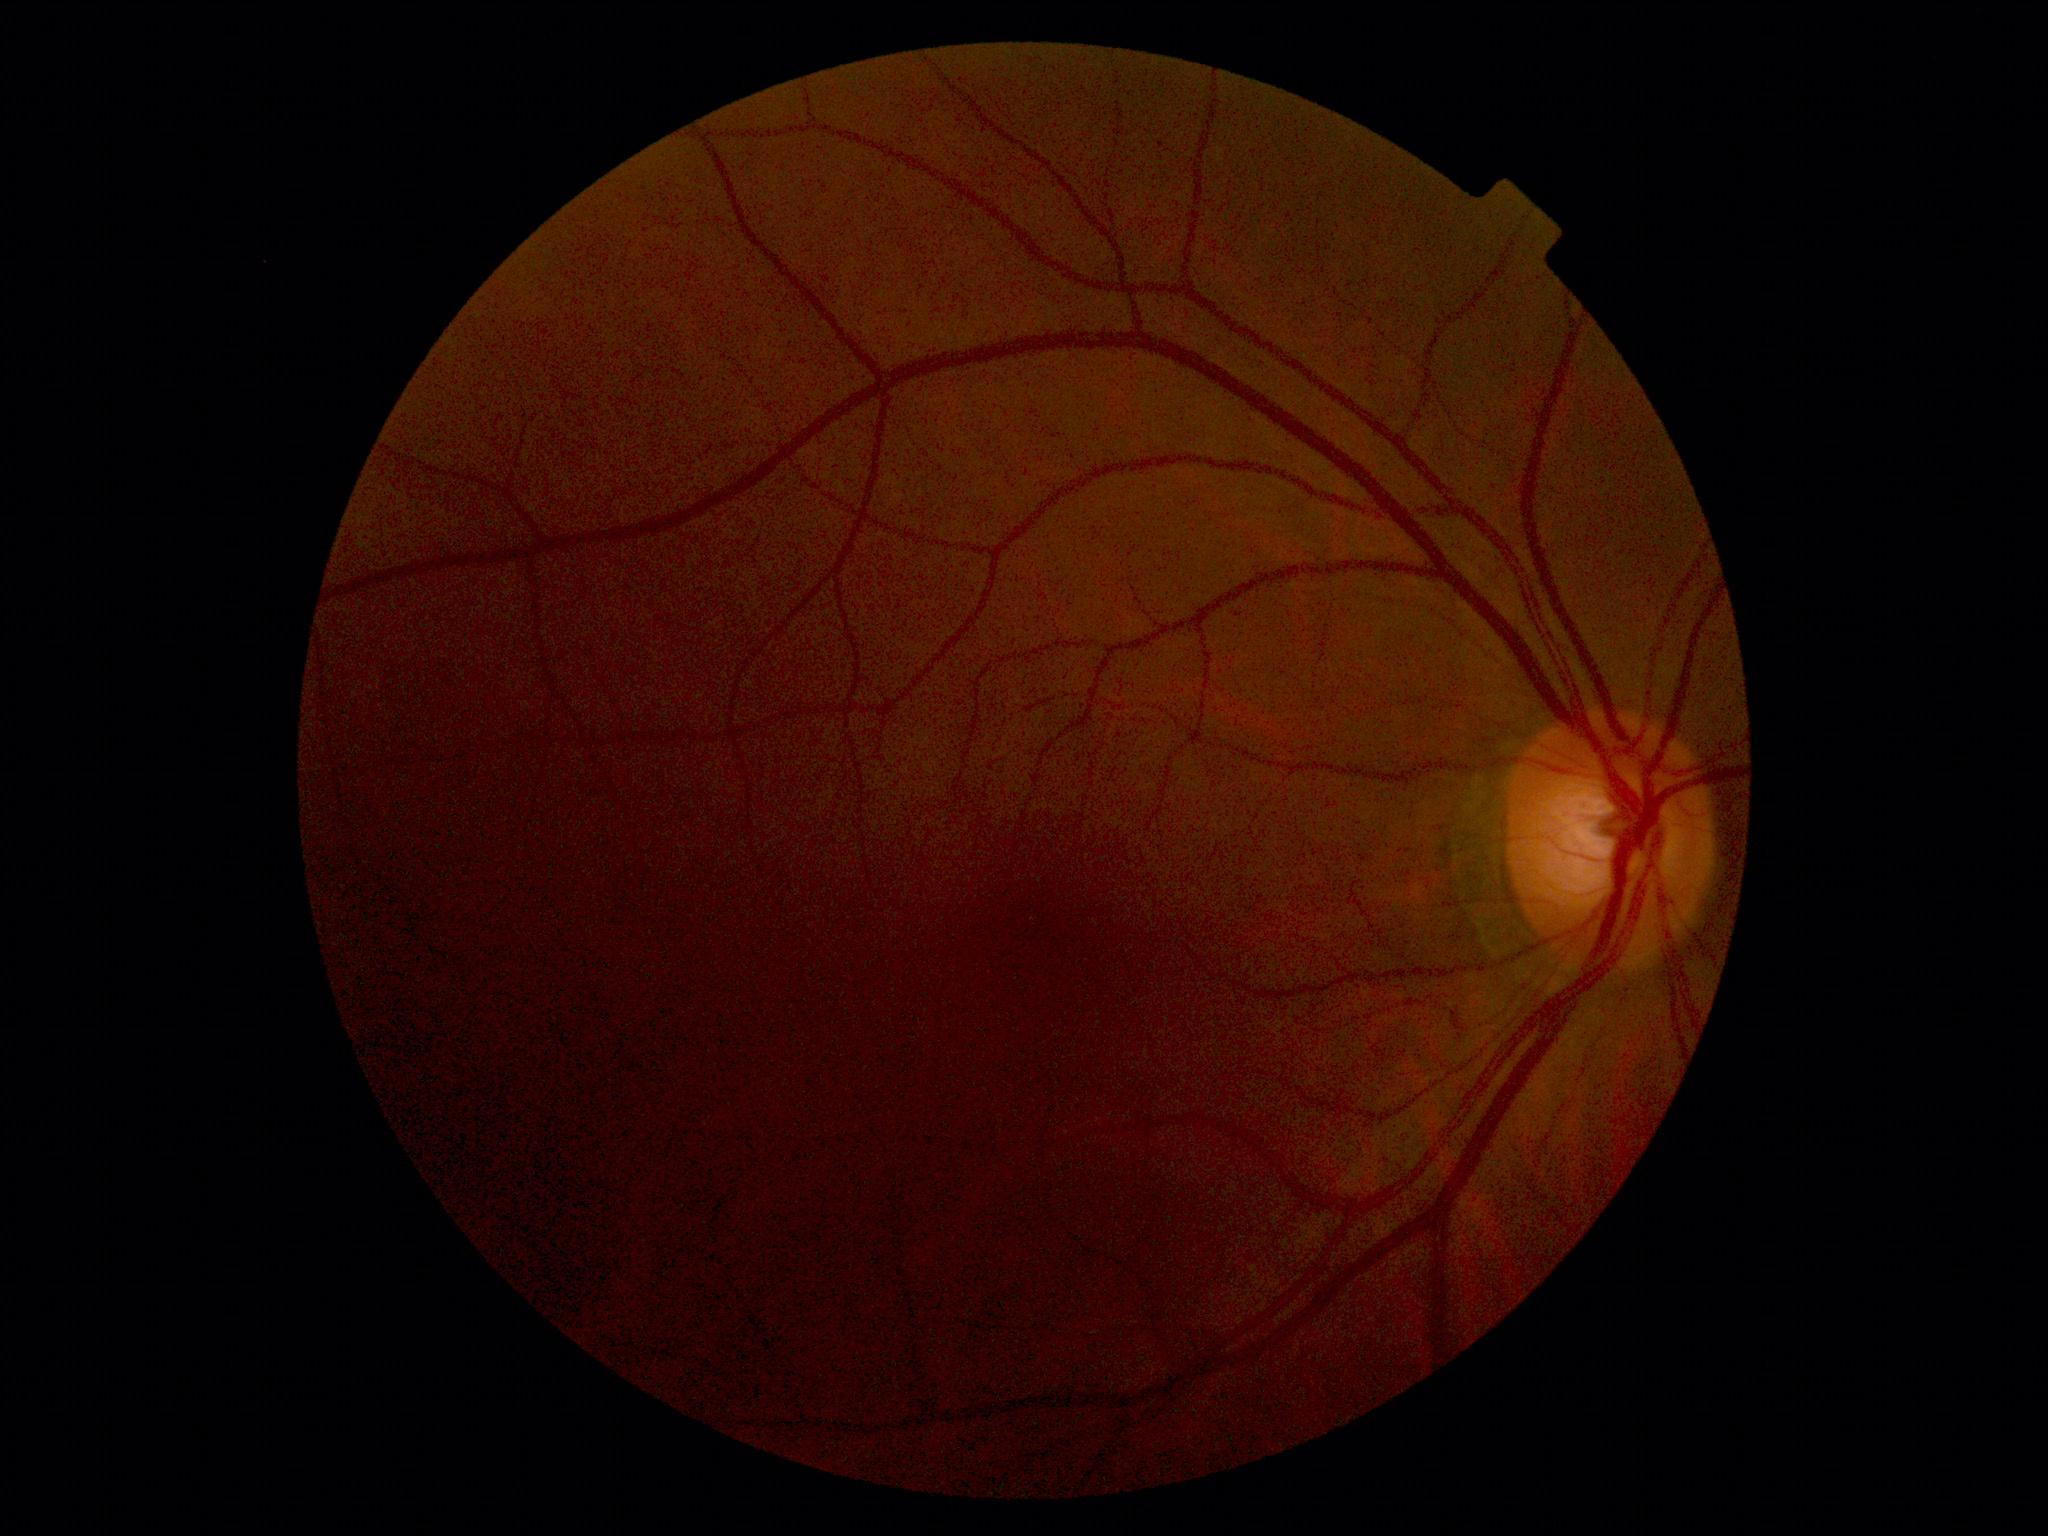 DR impression: negative for DR; diabetic retinopathy: grade 0 (no apparent retinopathy).